45° field of view. 2048 x 1536 pixels:
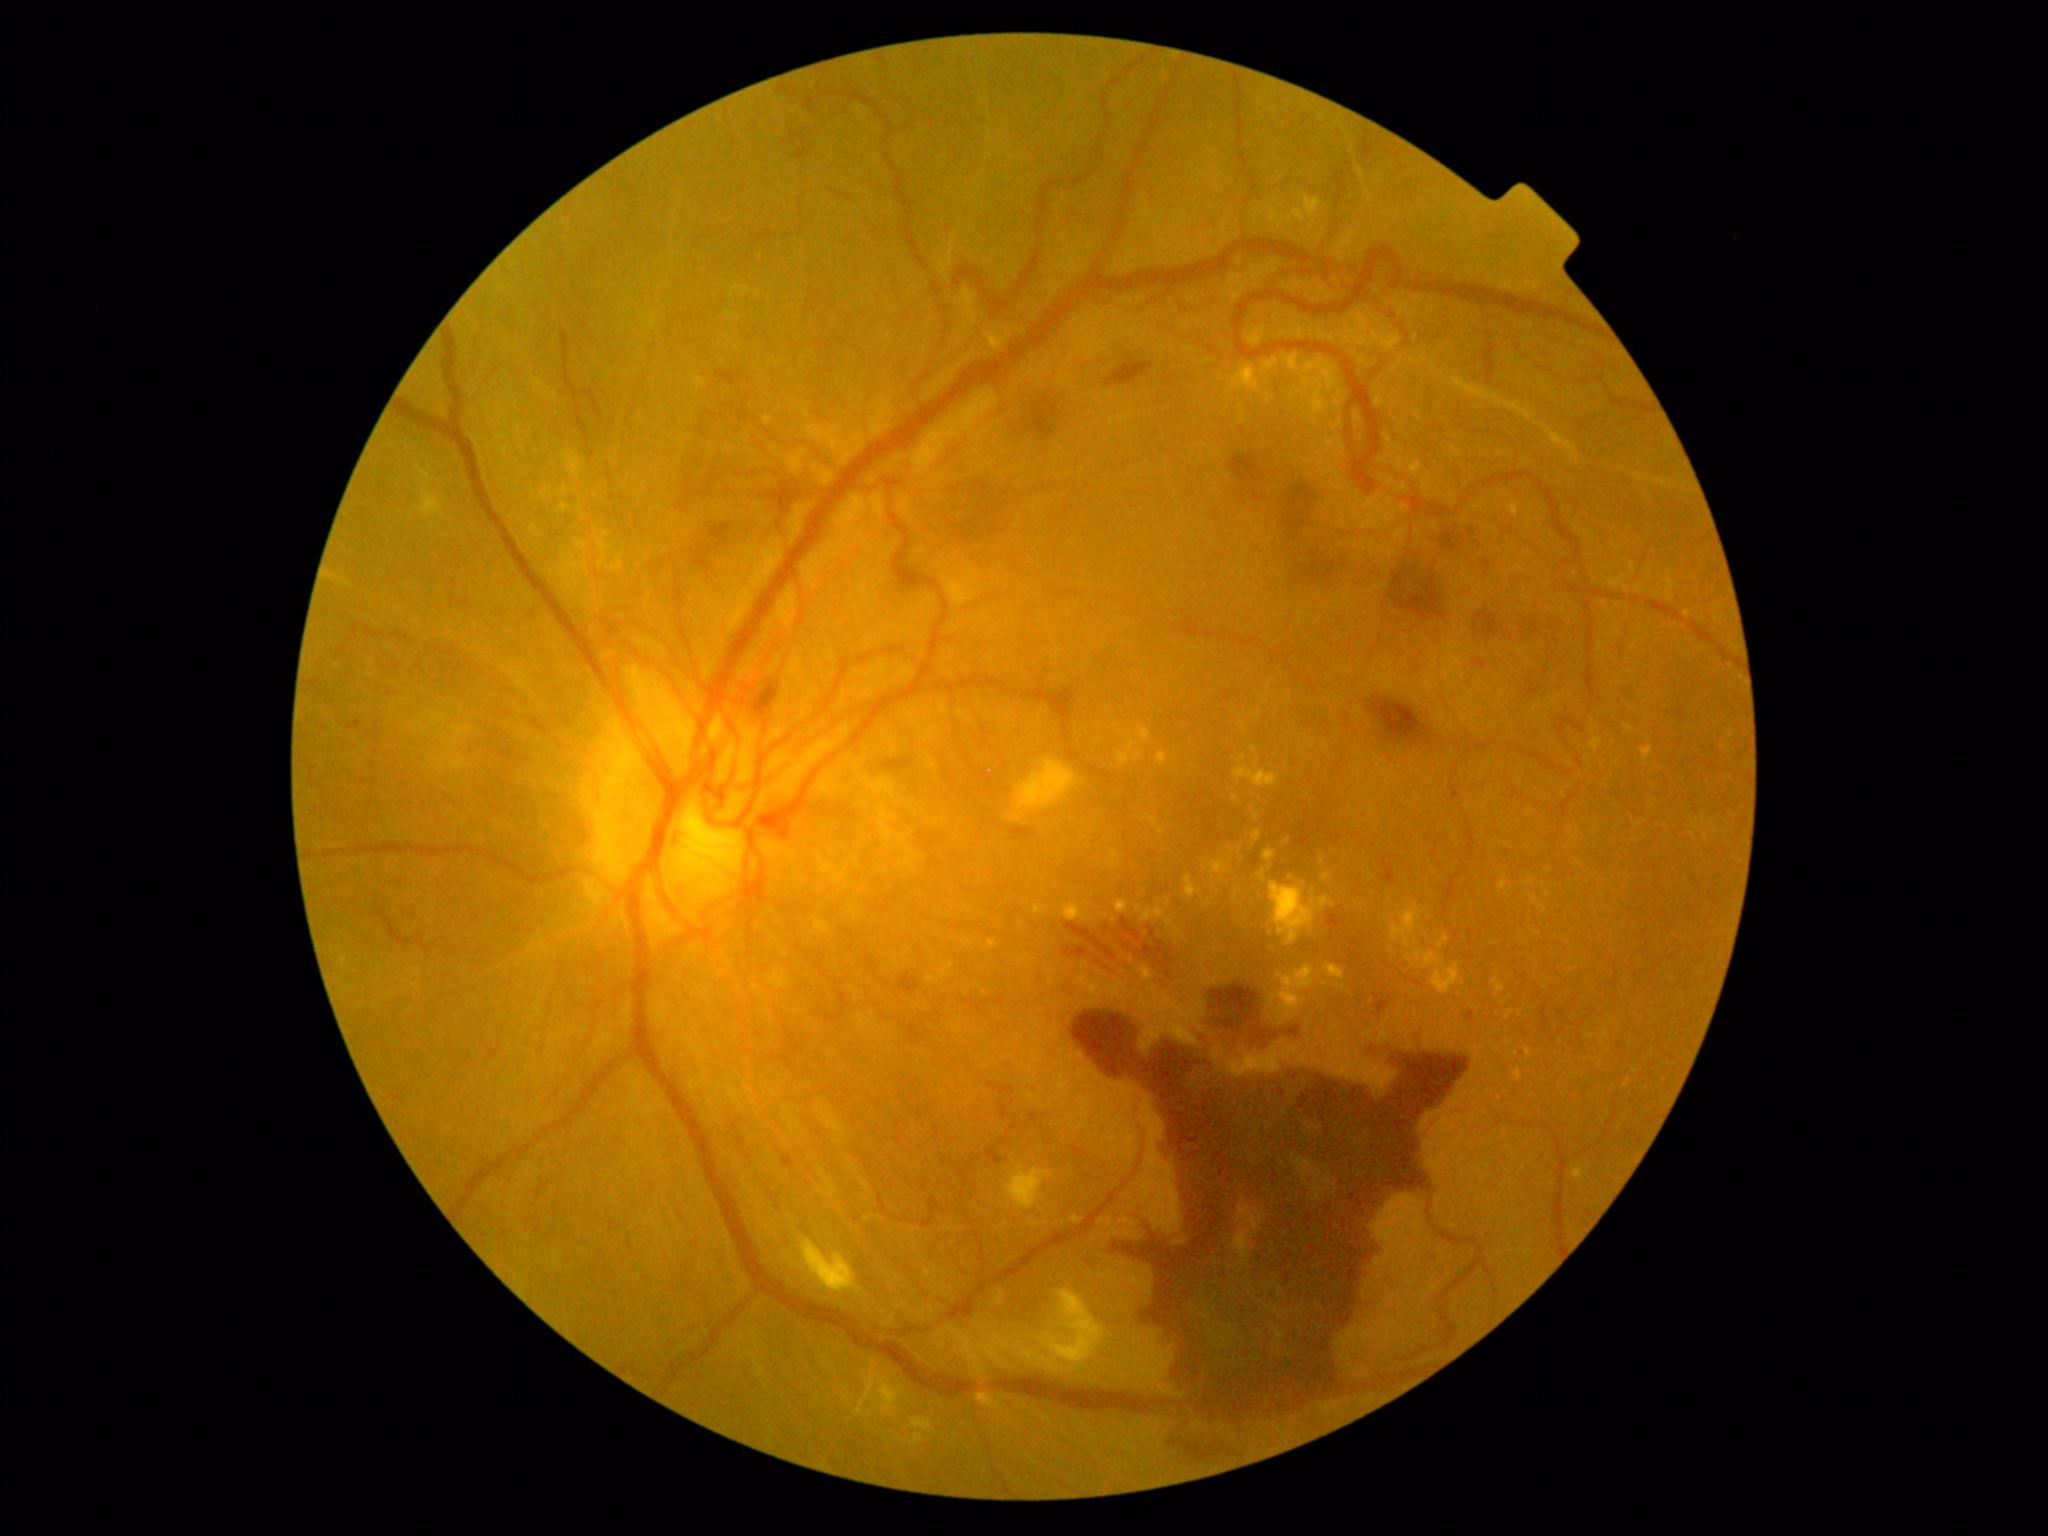 DR stage is 4/4 — neovascularization and/or vitreous/pre-retinal hemorrhage.
DR class: proliferative diabetic retinopathy.